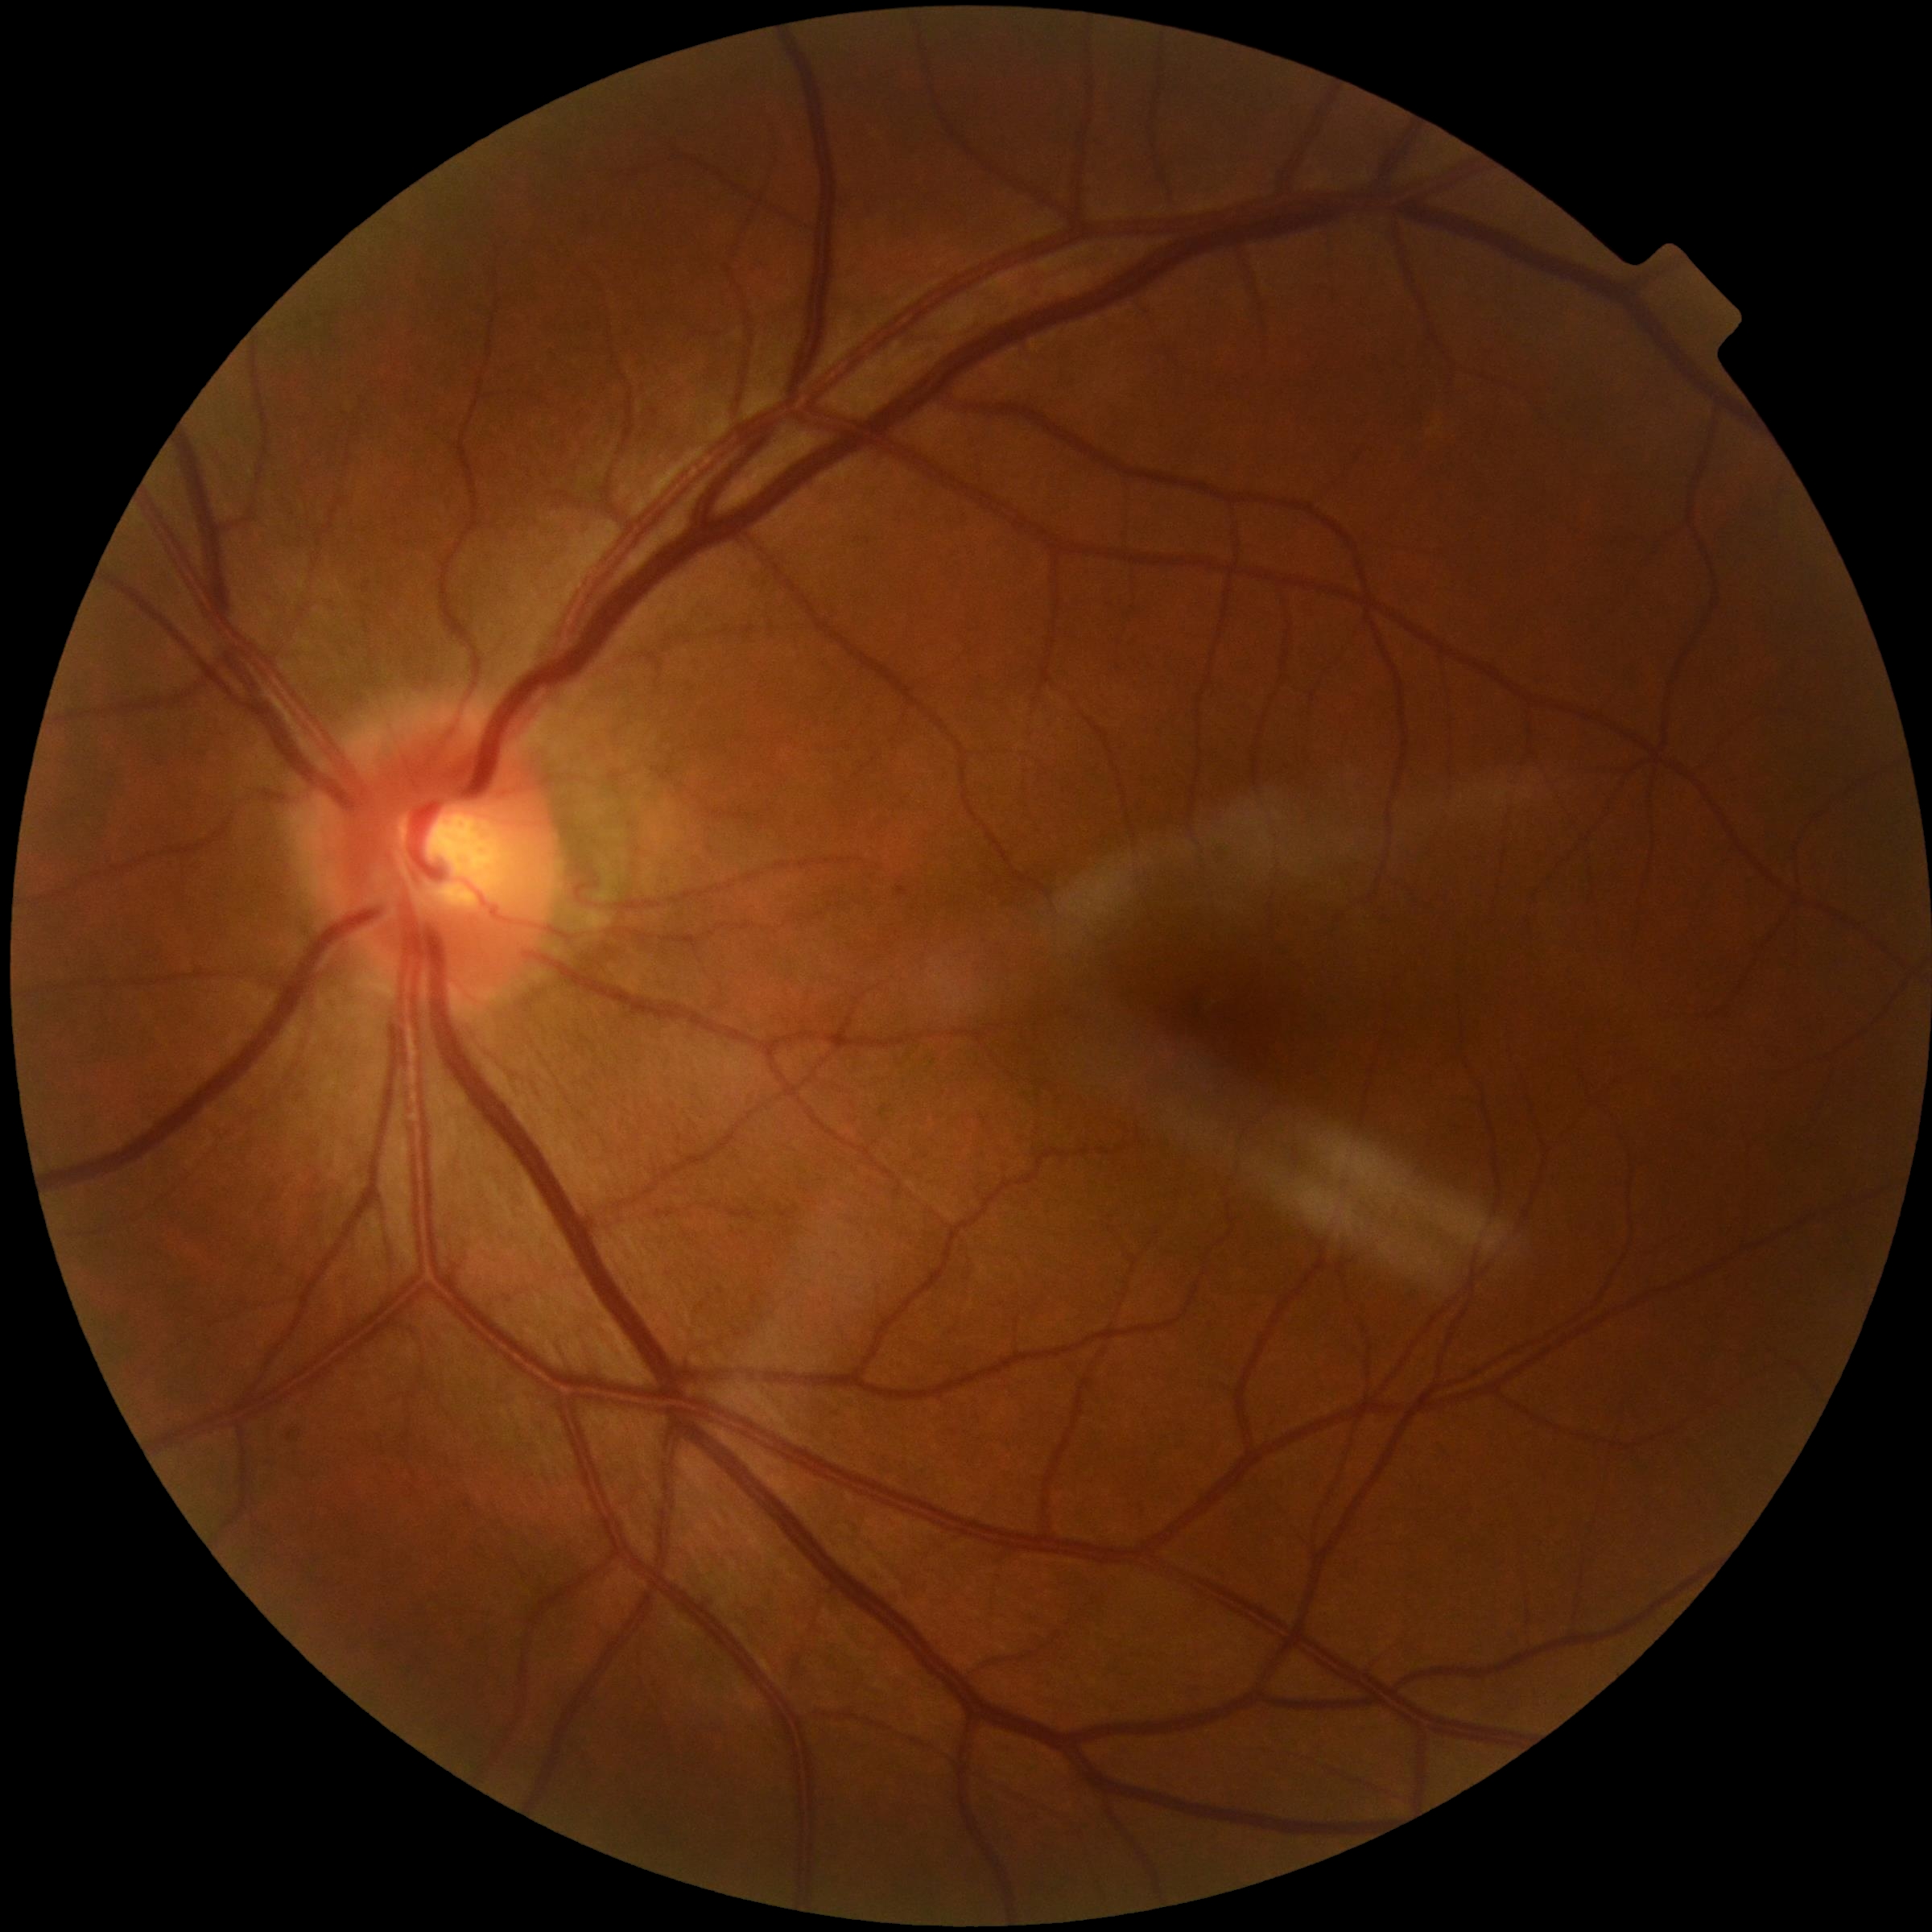 DR is grade 1.